45° field of view
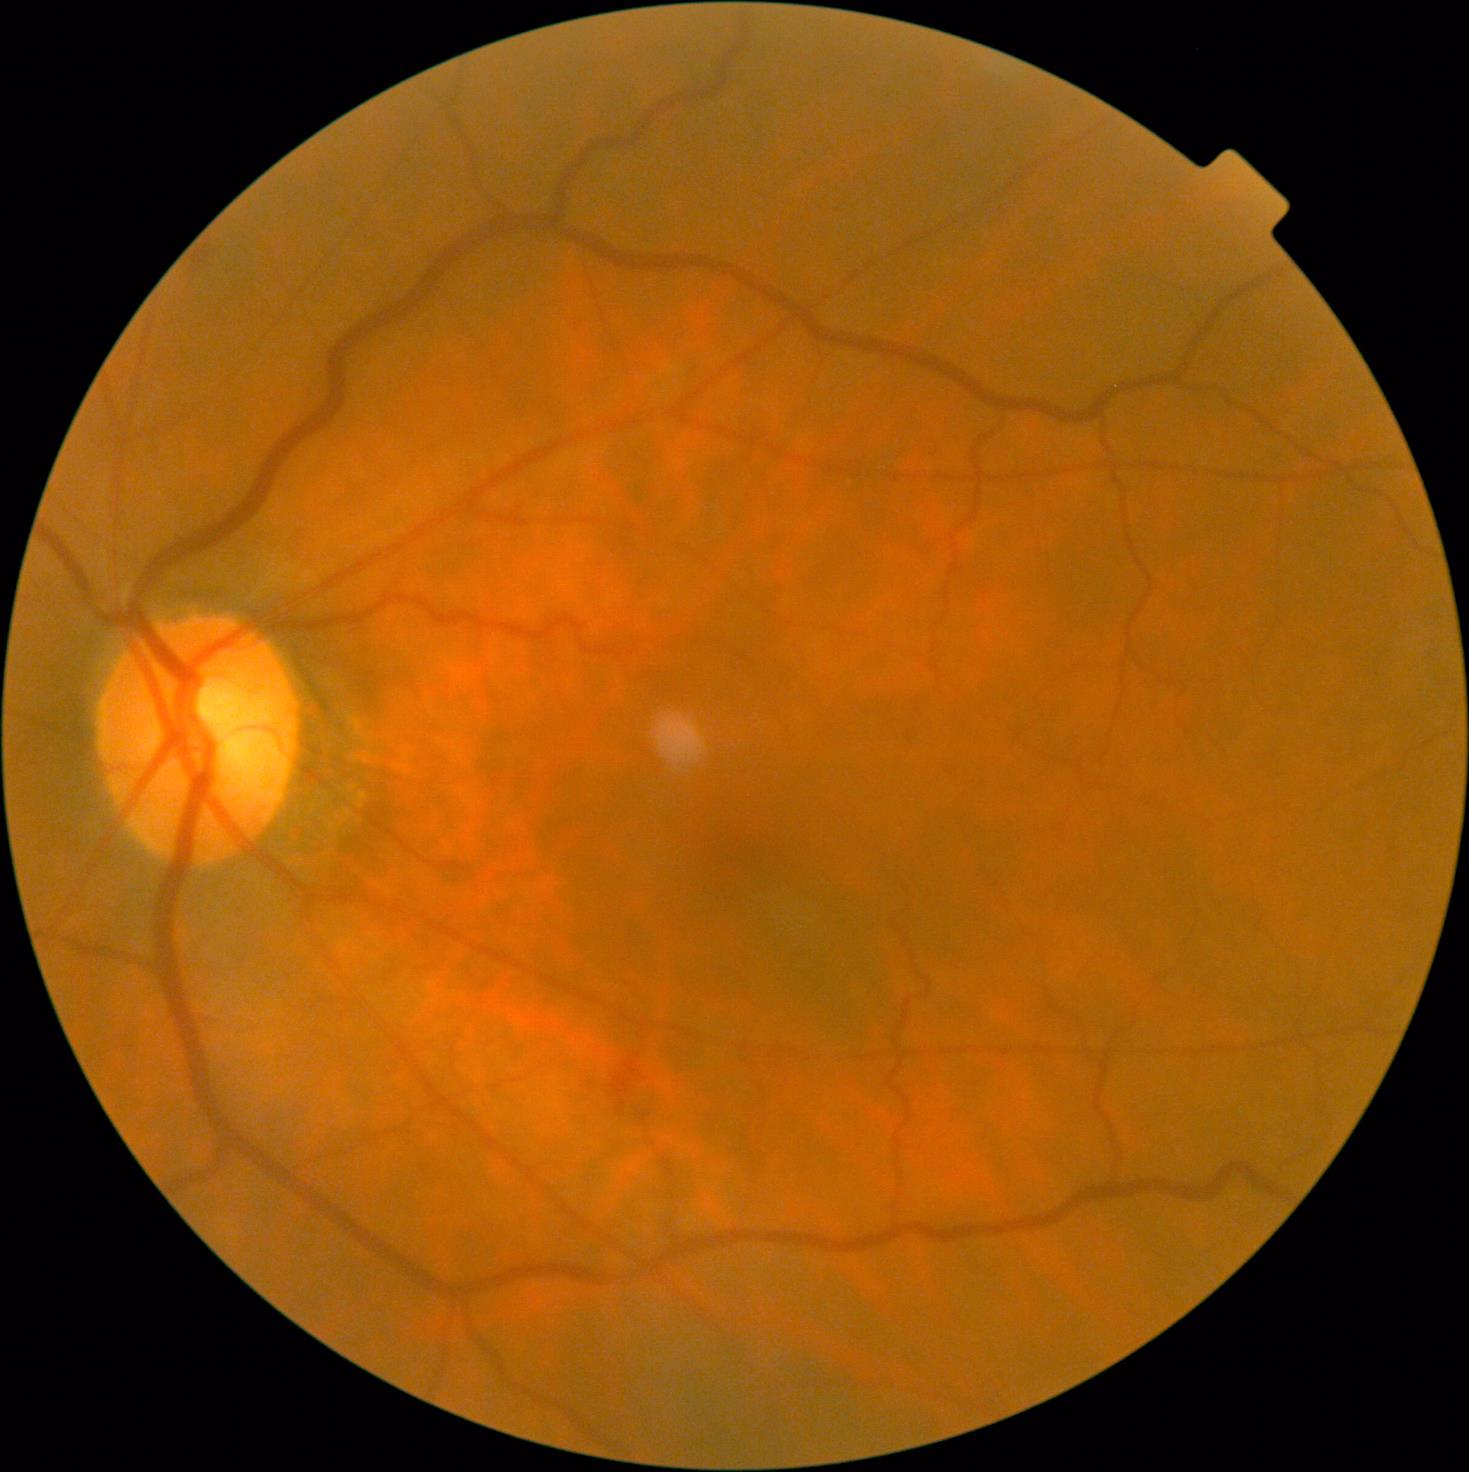 diabetic retinopathy (DR): moderate non-proliferative diabetic retinopathy (grade 2); DR class: non-proliferative diabetic retinopathy.